Acquired with a NIDEK AFC-230 · posterior pole color fundus photograph · 45 degree fundus photograph.
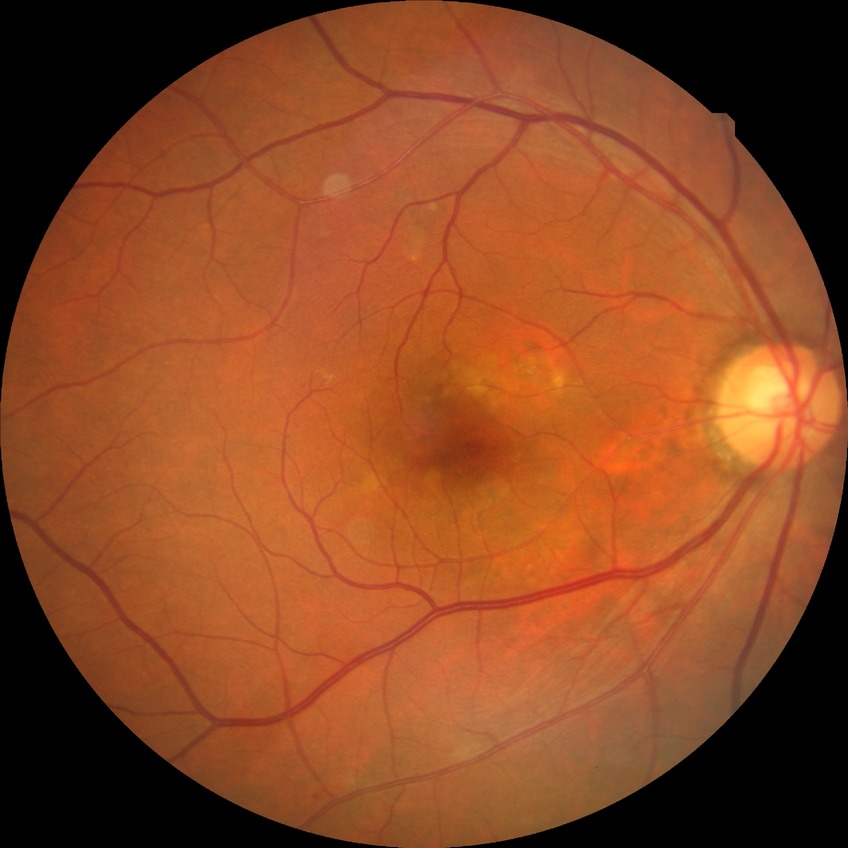

  davis_grade: no diabetic retinopathy